Acquired with a NIDEK AFC-230
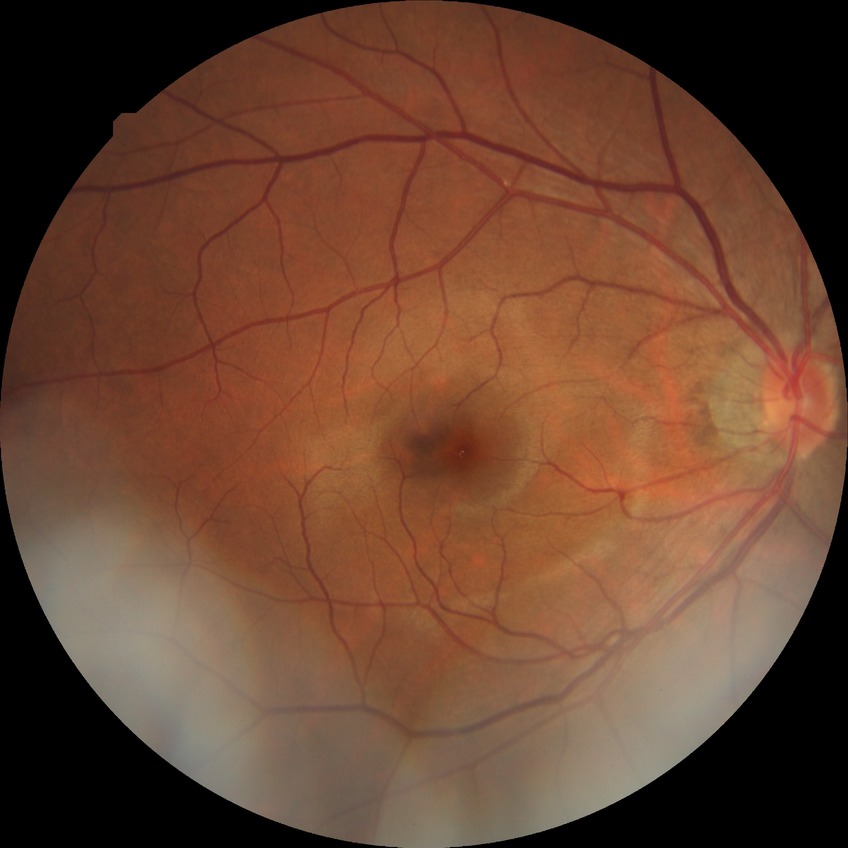 {
  "davis_grade": "NDR (no diabetic retinopathy)"
}